Without pupil dilation. 45 degree fundus photograph. NIDEK AFC-230 fundus camera. Posterior pole photograph: 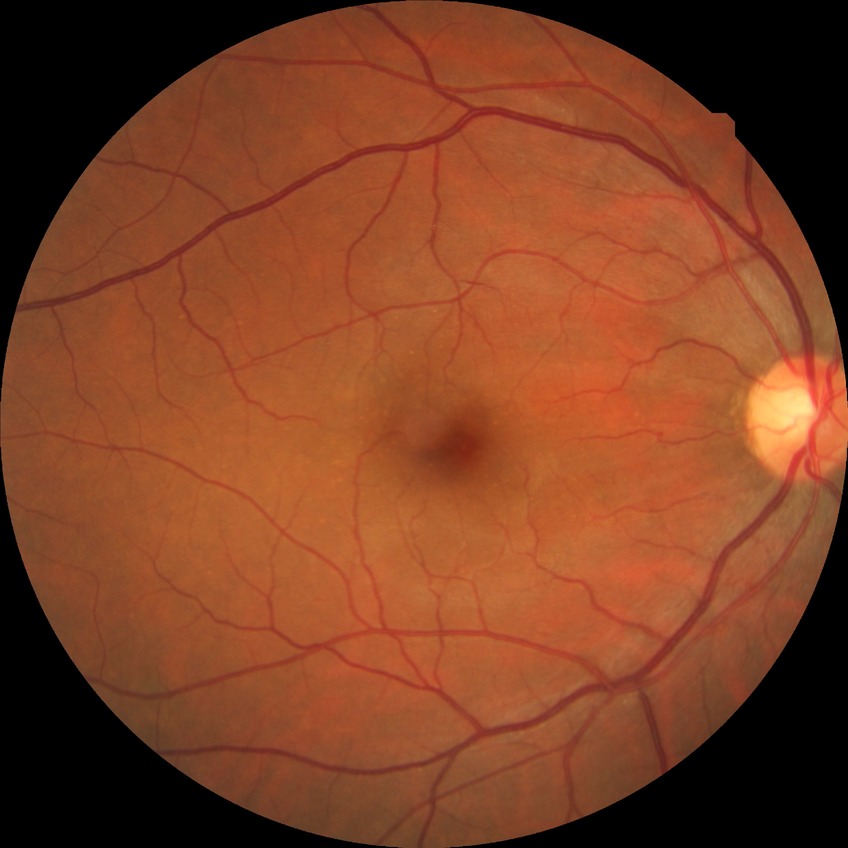

diabetic retinopathy (DR) = NDR (no diabetic retinopathy)